1536 x 1152 pixels; FOV: 45 degrees:
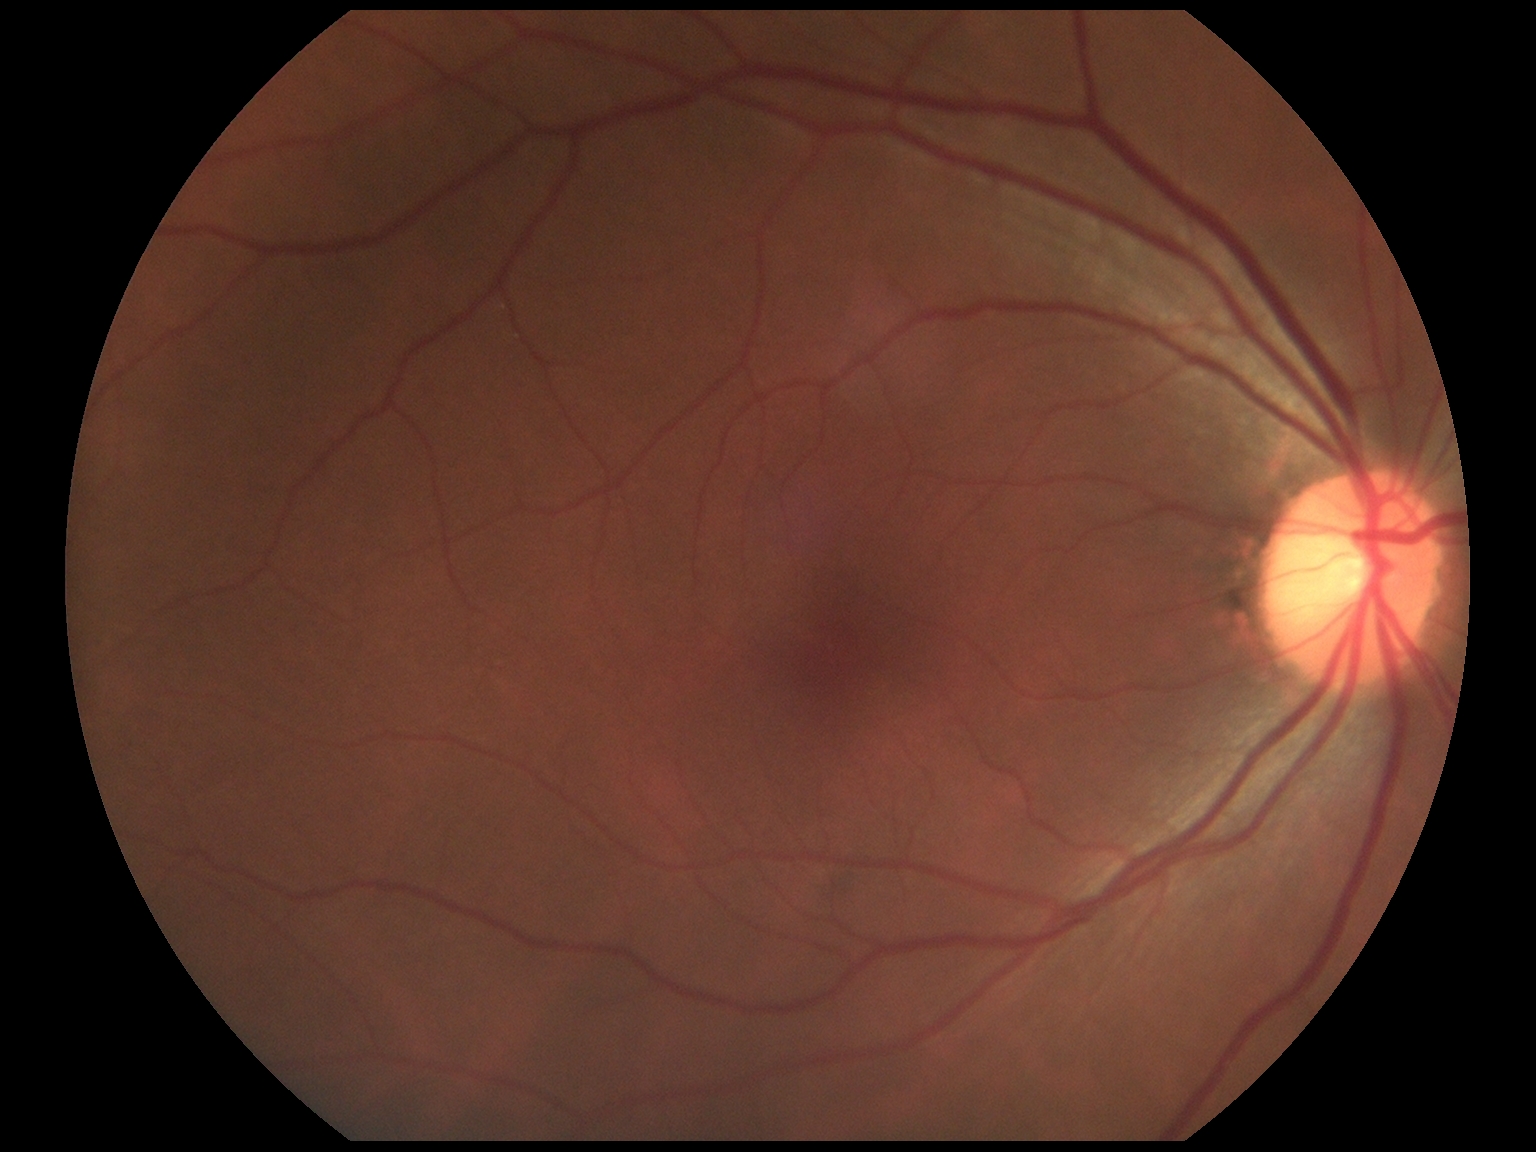 DR impression: no apparent DR
retinopathy grade: 0 — no visible signs of diabetic retinopathy